Retinal fundus photograph: 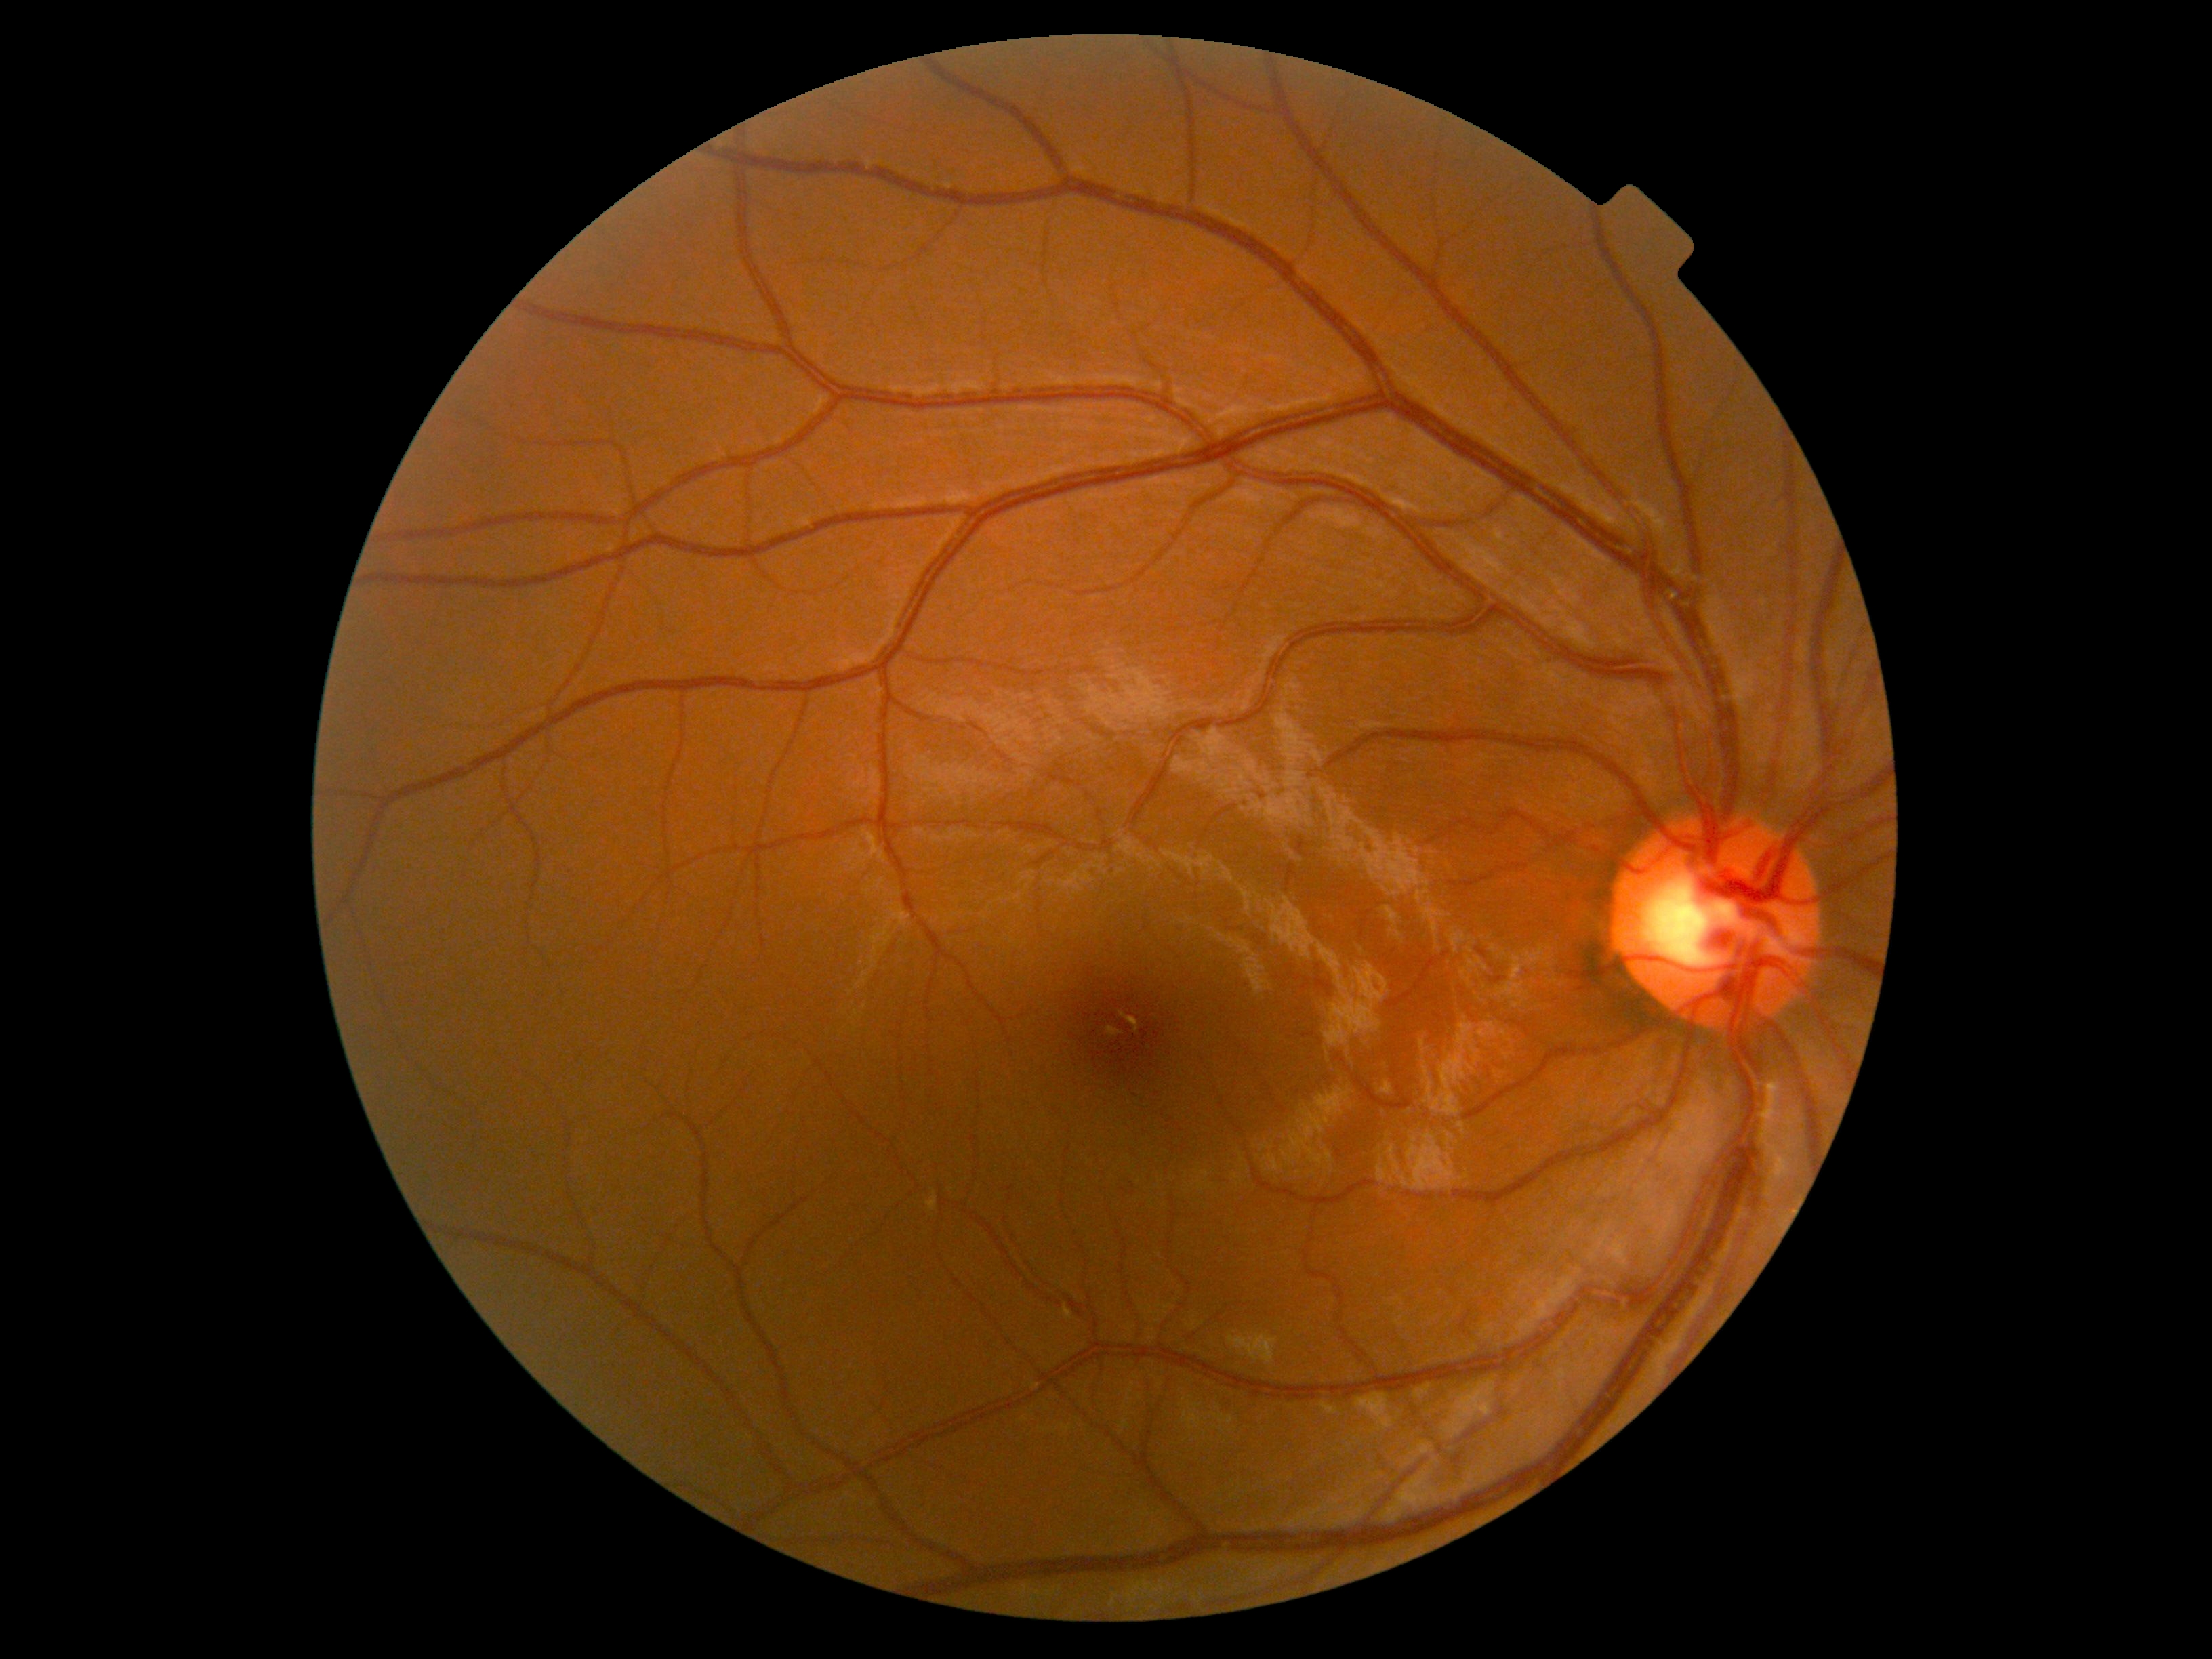
Annotations:
- DR severity — grade 0
- DR impression — no DR findings